Posterior pole photograph; without pupil dilation; image size 848x848; camera: NIDEK AFC-230; FOV: 45 degrees
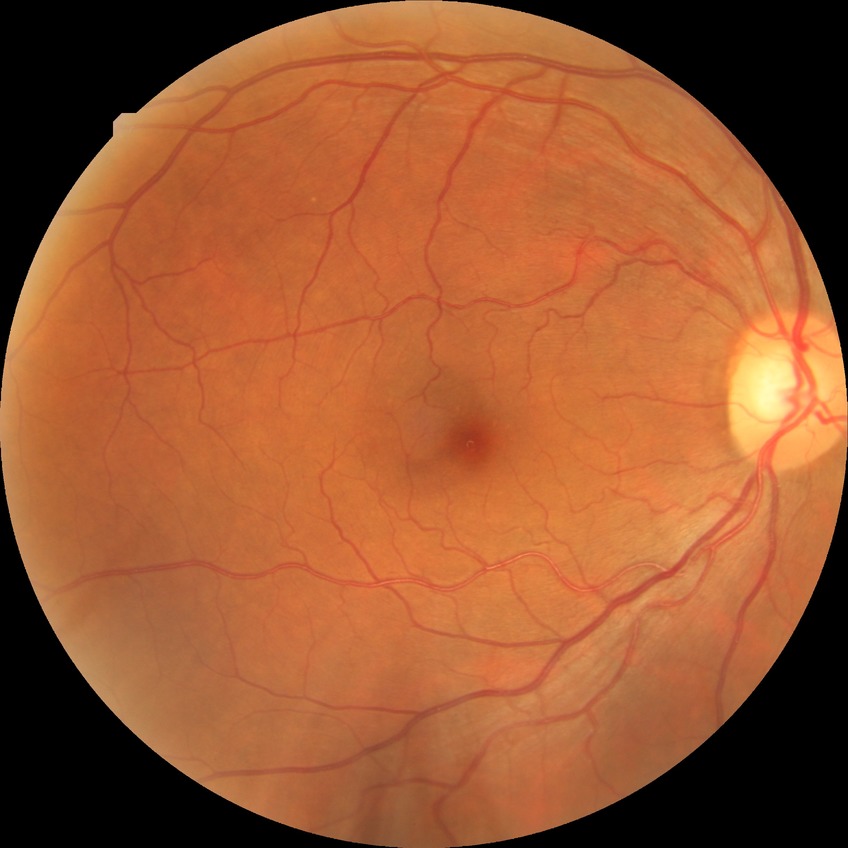

Diabetic retinopathy (DR) is SDR (simple diabetic retinopathy).